240x240; color fundus photograph
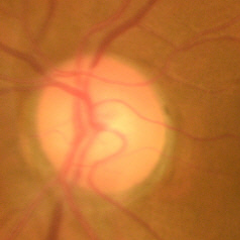 Optic disc appearance consistent with no glaucomatous optic neuropathy.